CFP: 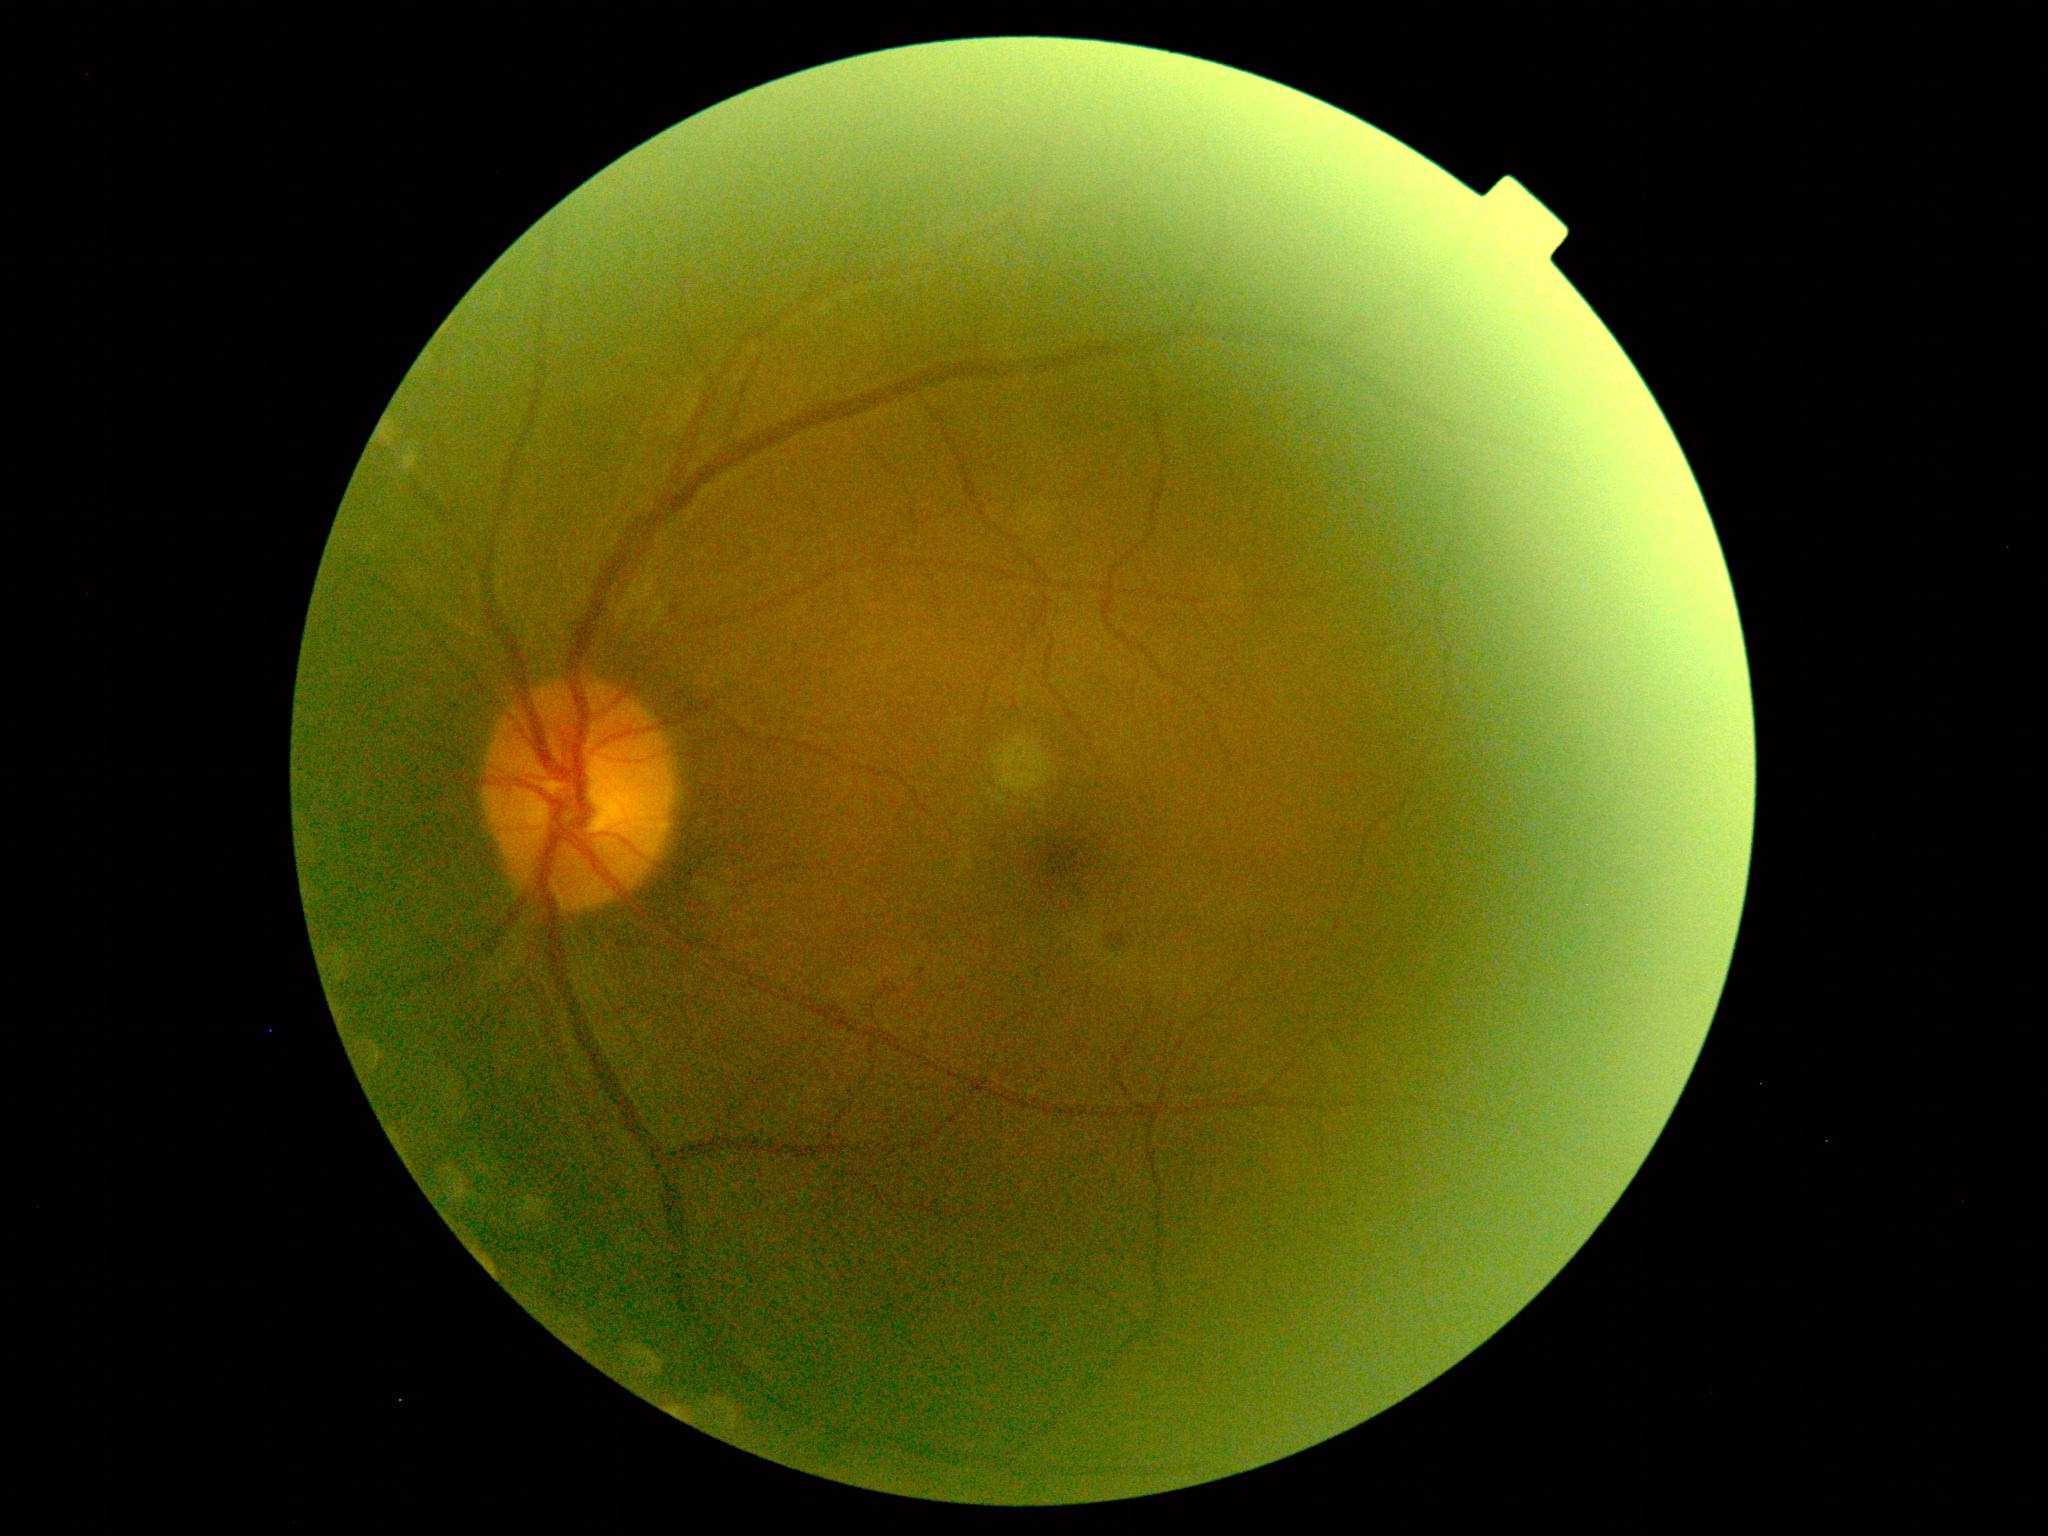
DR stage: 2. The retinopathy is classified as non-proliferative diabetic retinopathy.